Infant wide-field retinal image; acquired on the Clarity RetCam 3
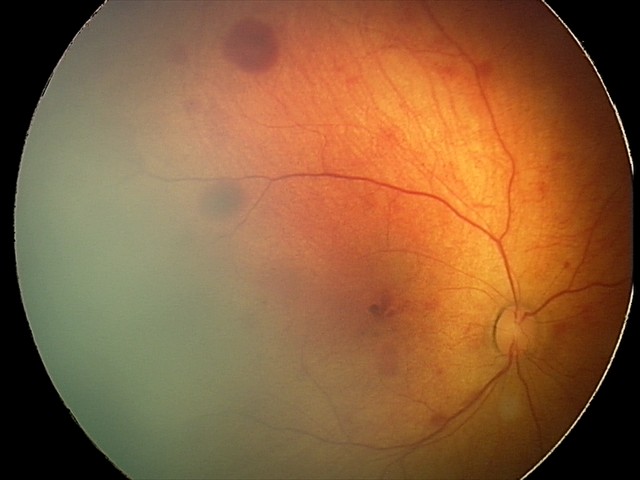

Examination diagnosed as retinal hemorrhages.